Image size 848x848
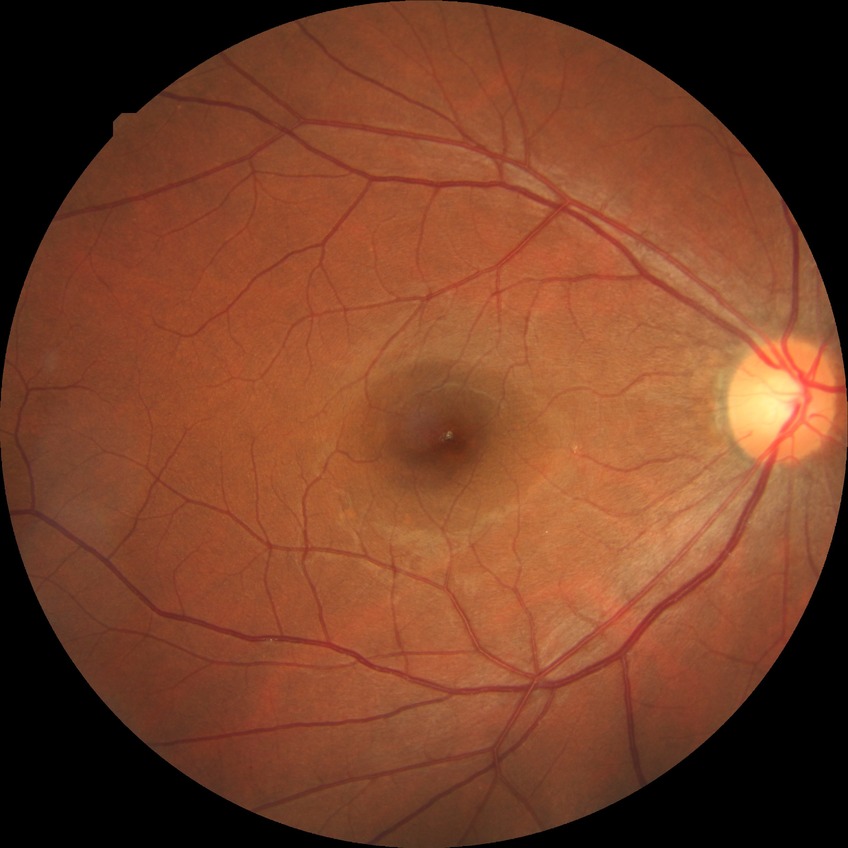

Diabetic retinopathy (DR): NDR (no diabetic retinopathy).